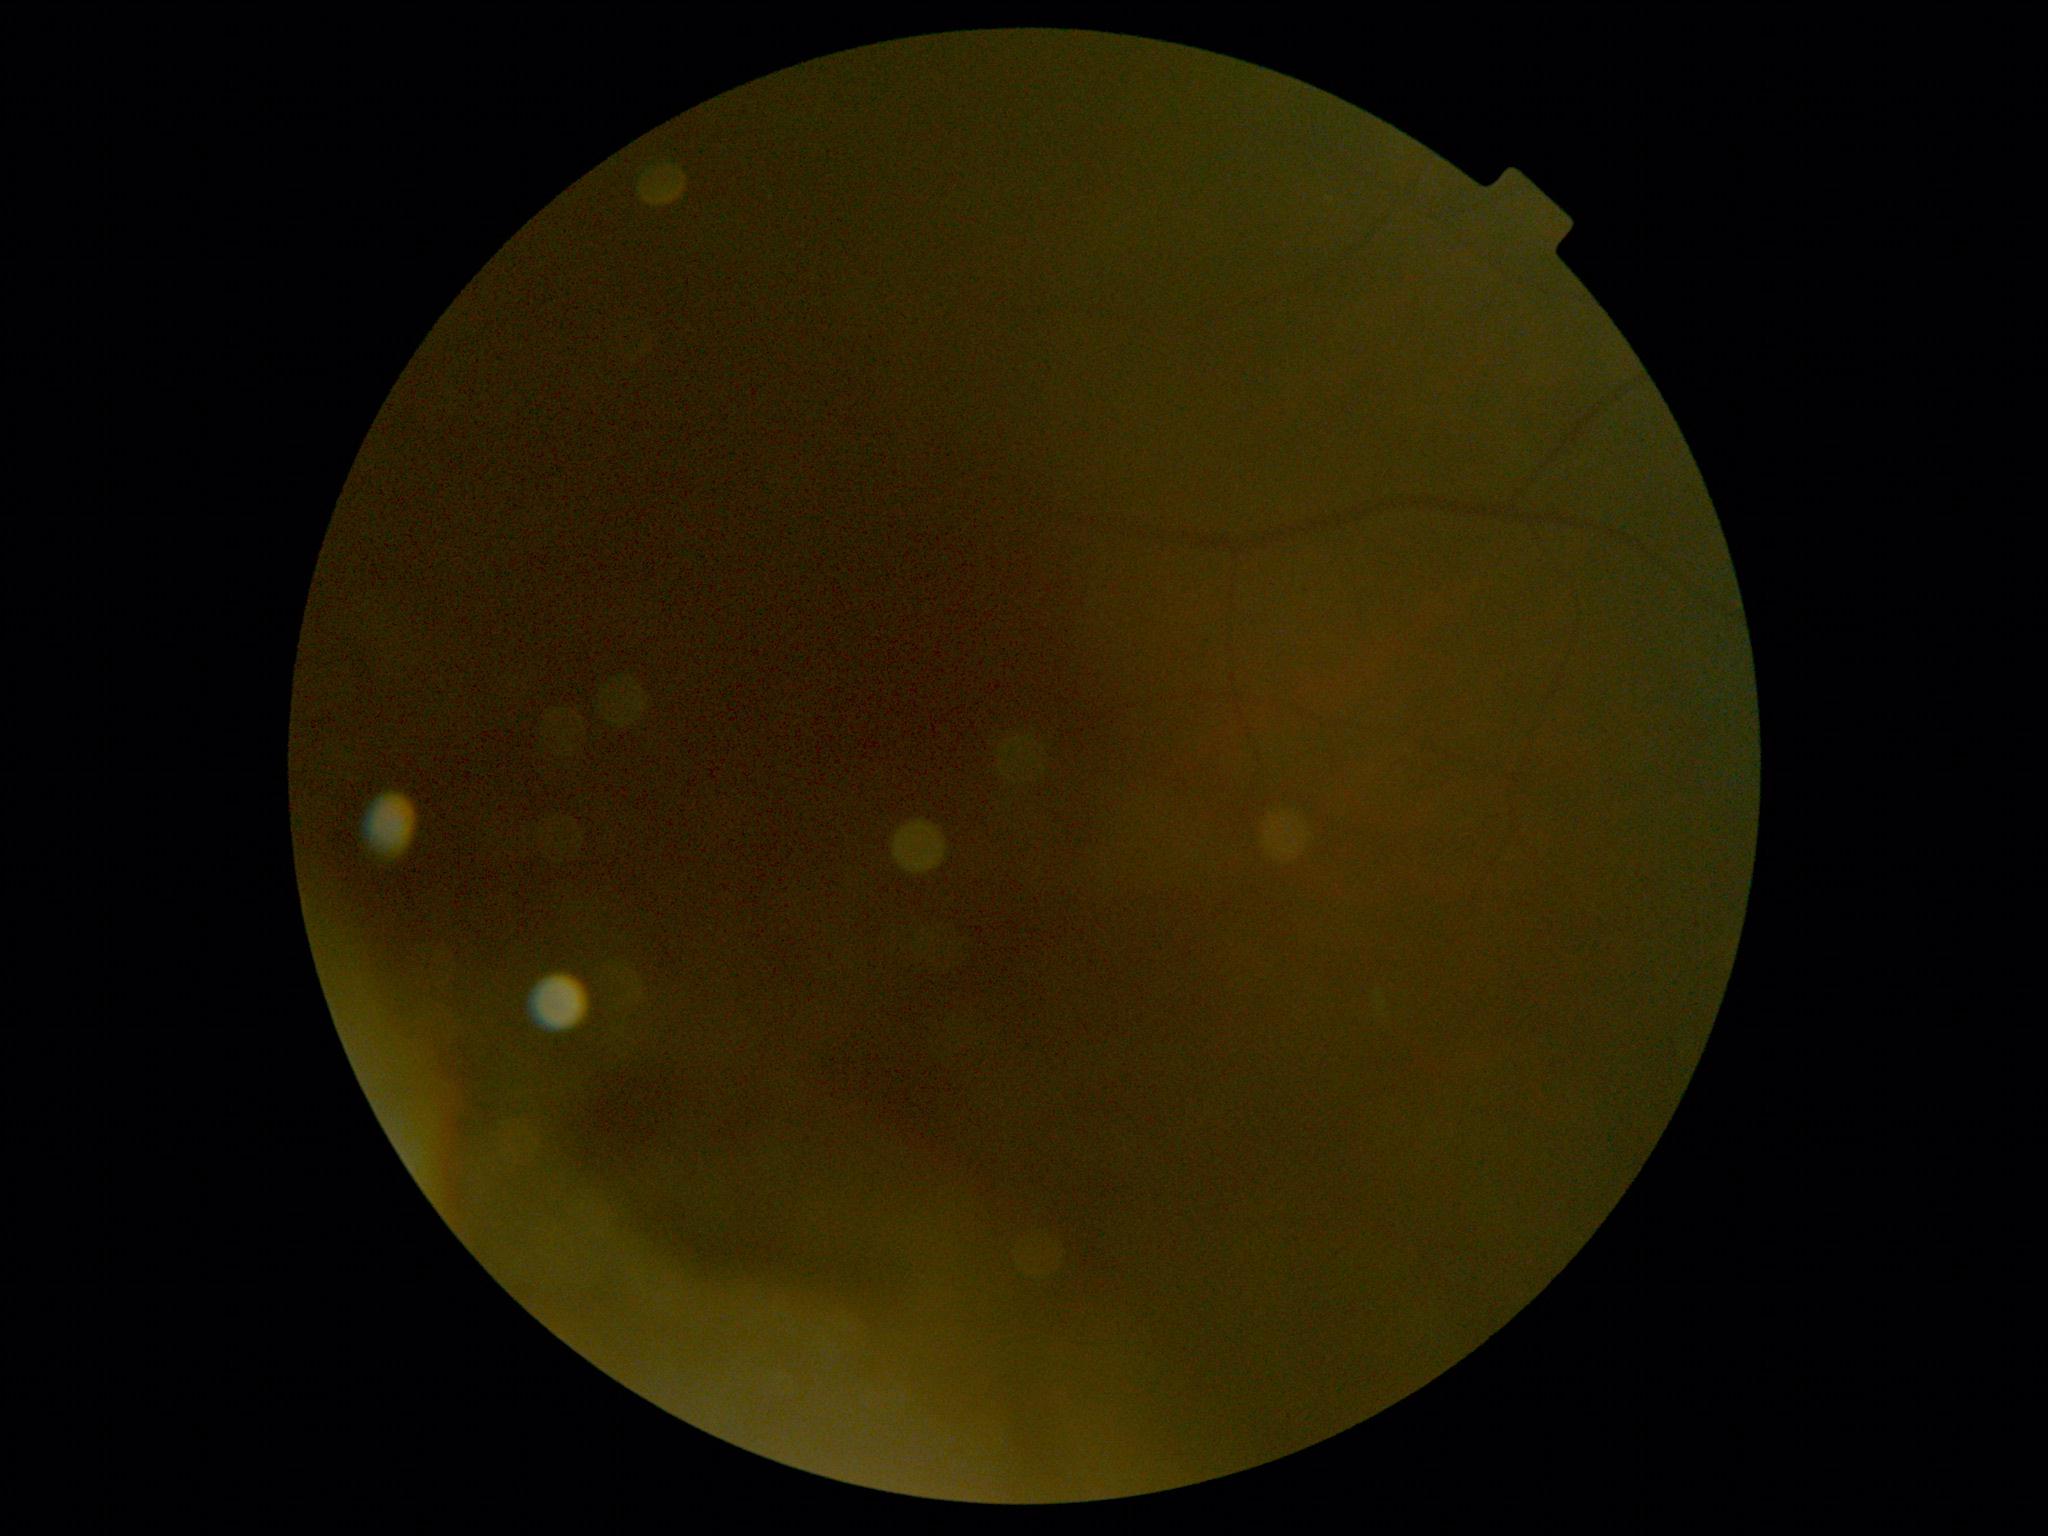 Diabetic retinopathy (DR) is ungradable.